848x848. Fundus photo. 45° field of view: 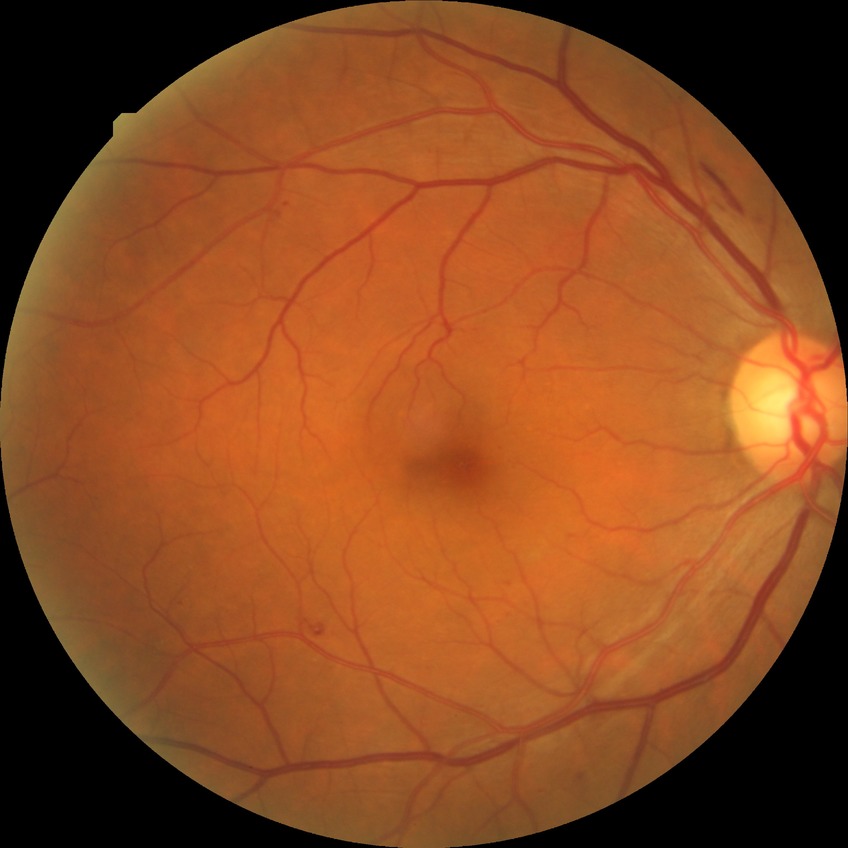 Modified Davis grading is simple diabetic retinopathy.